45° FOV
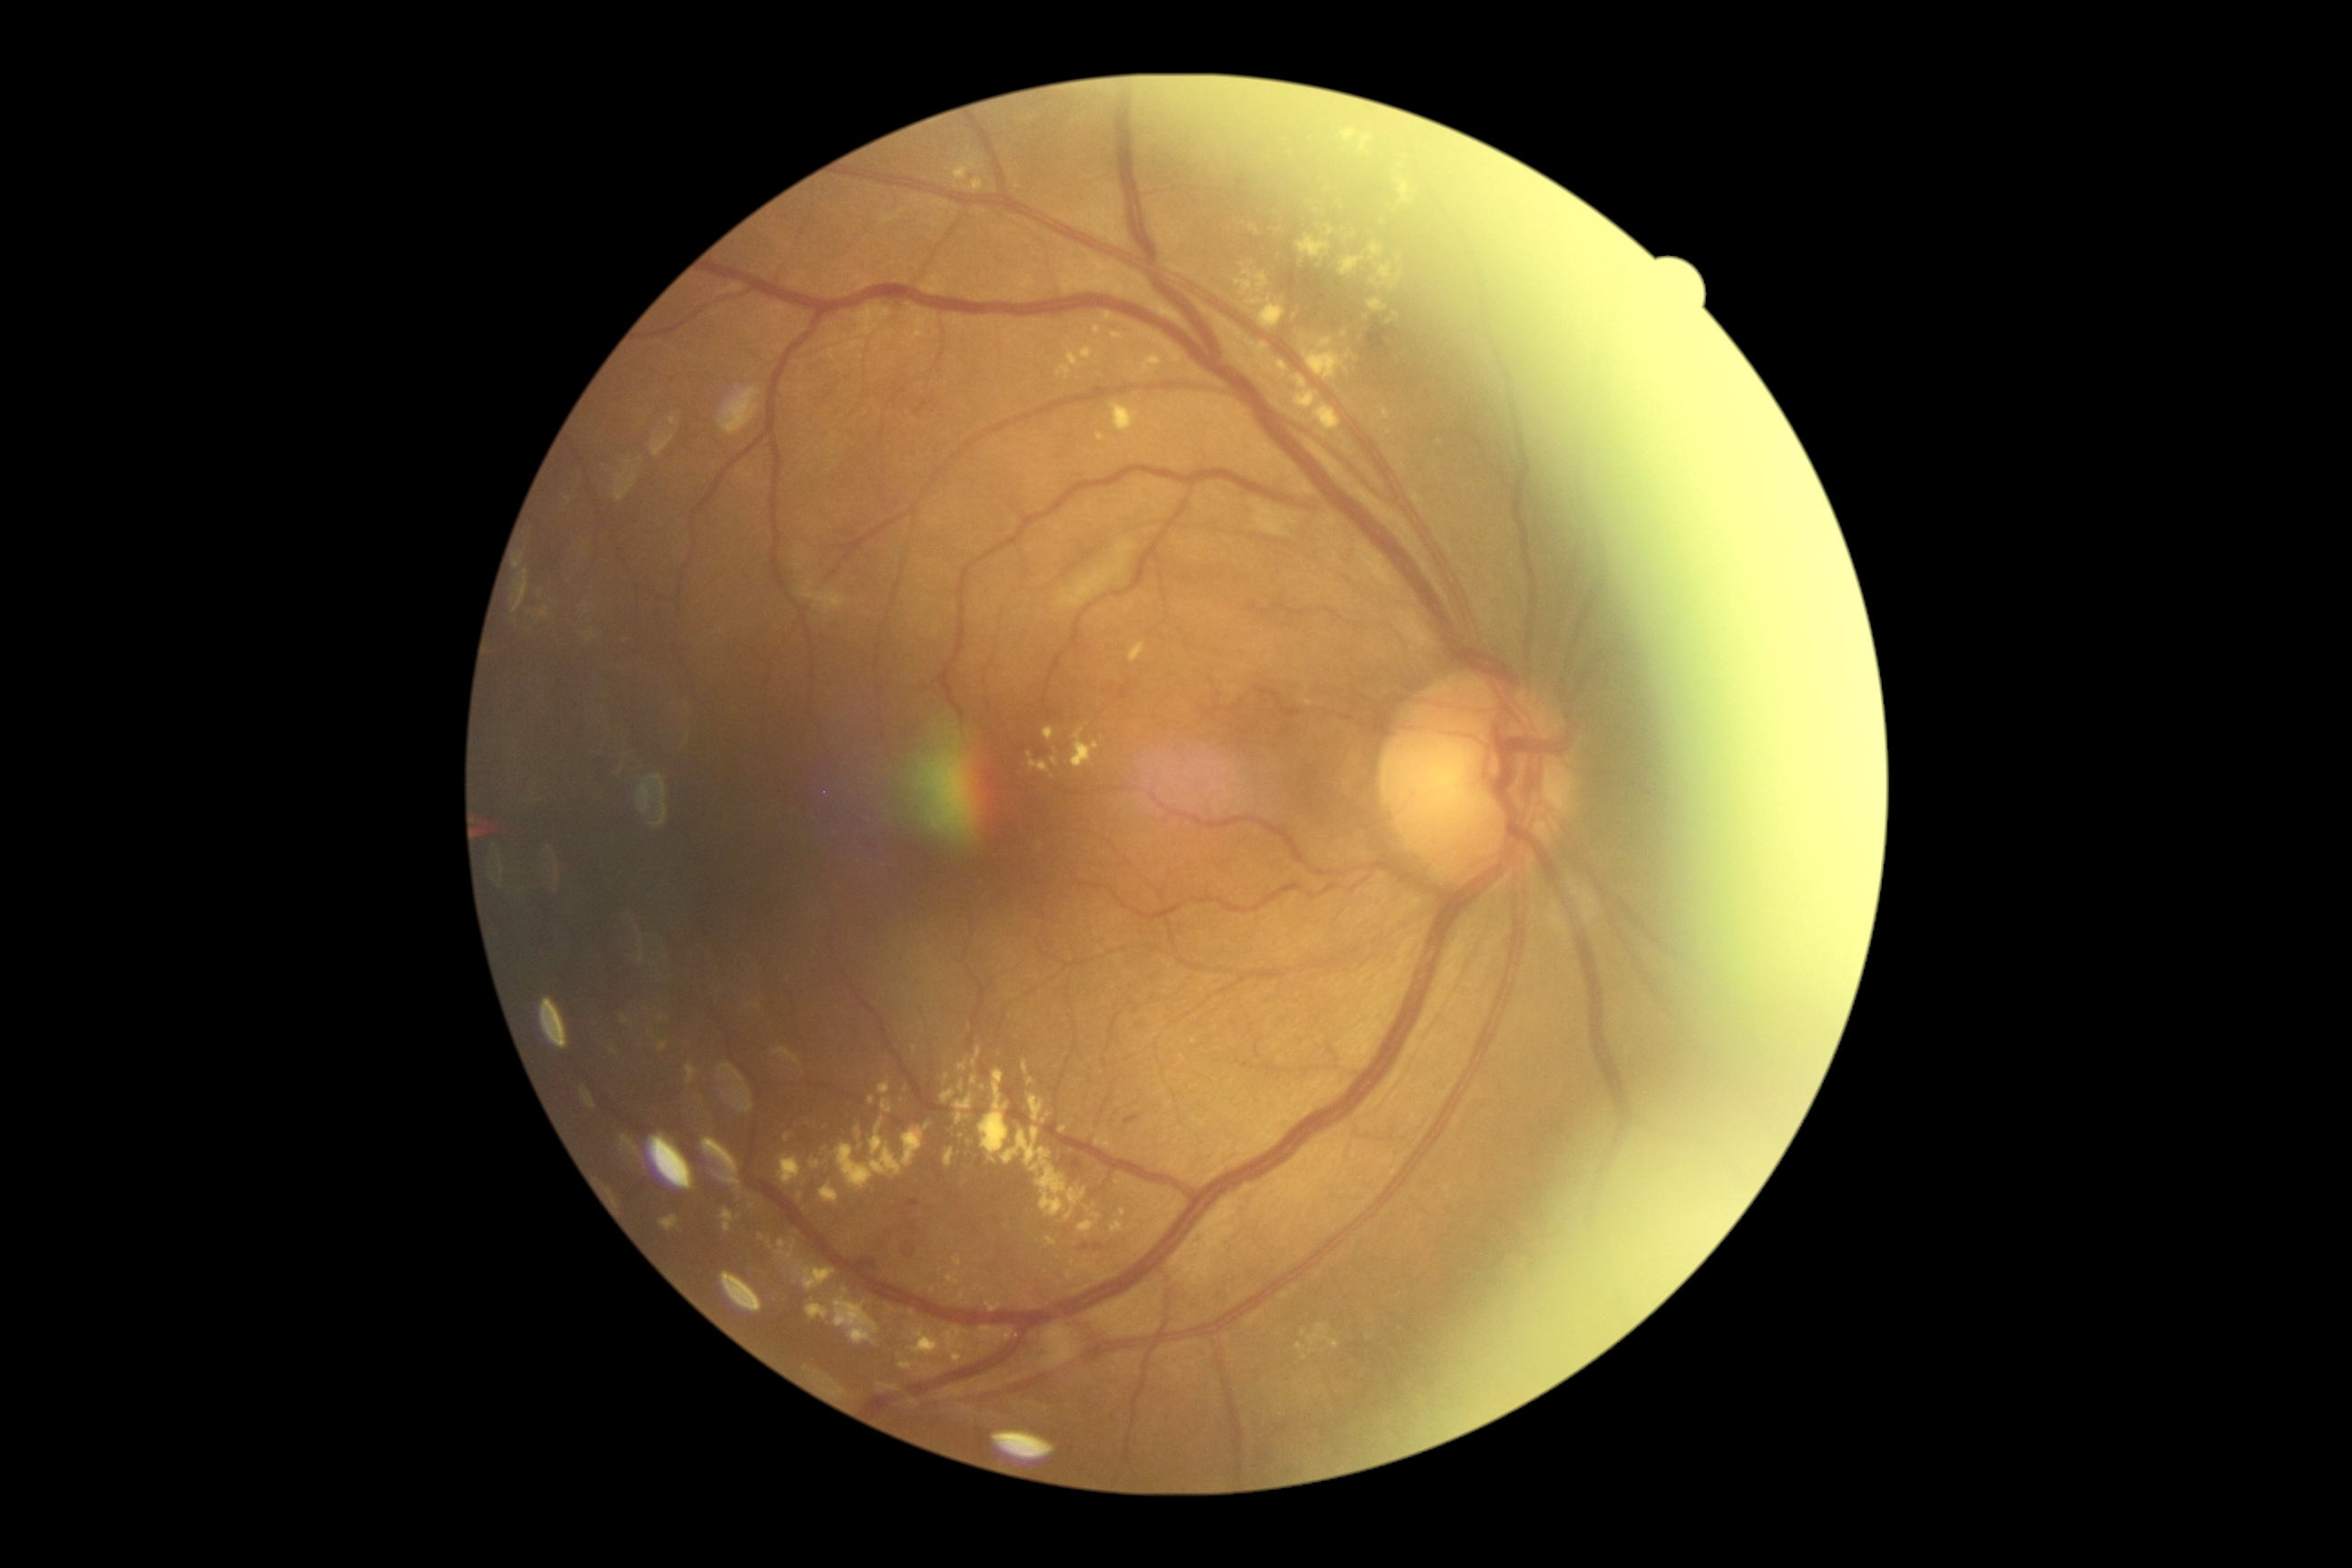
diabetic retinopathy (DR)=grade 2.